2048 x 1536 pixels
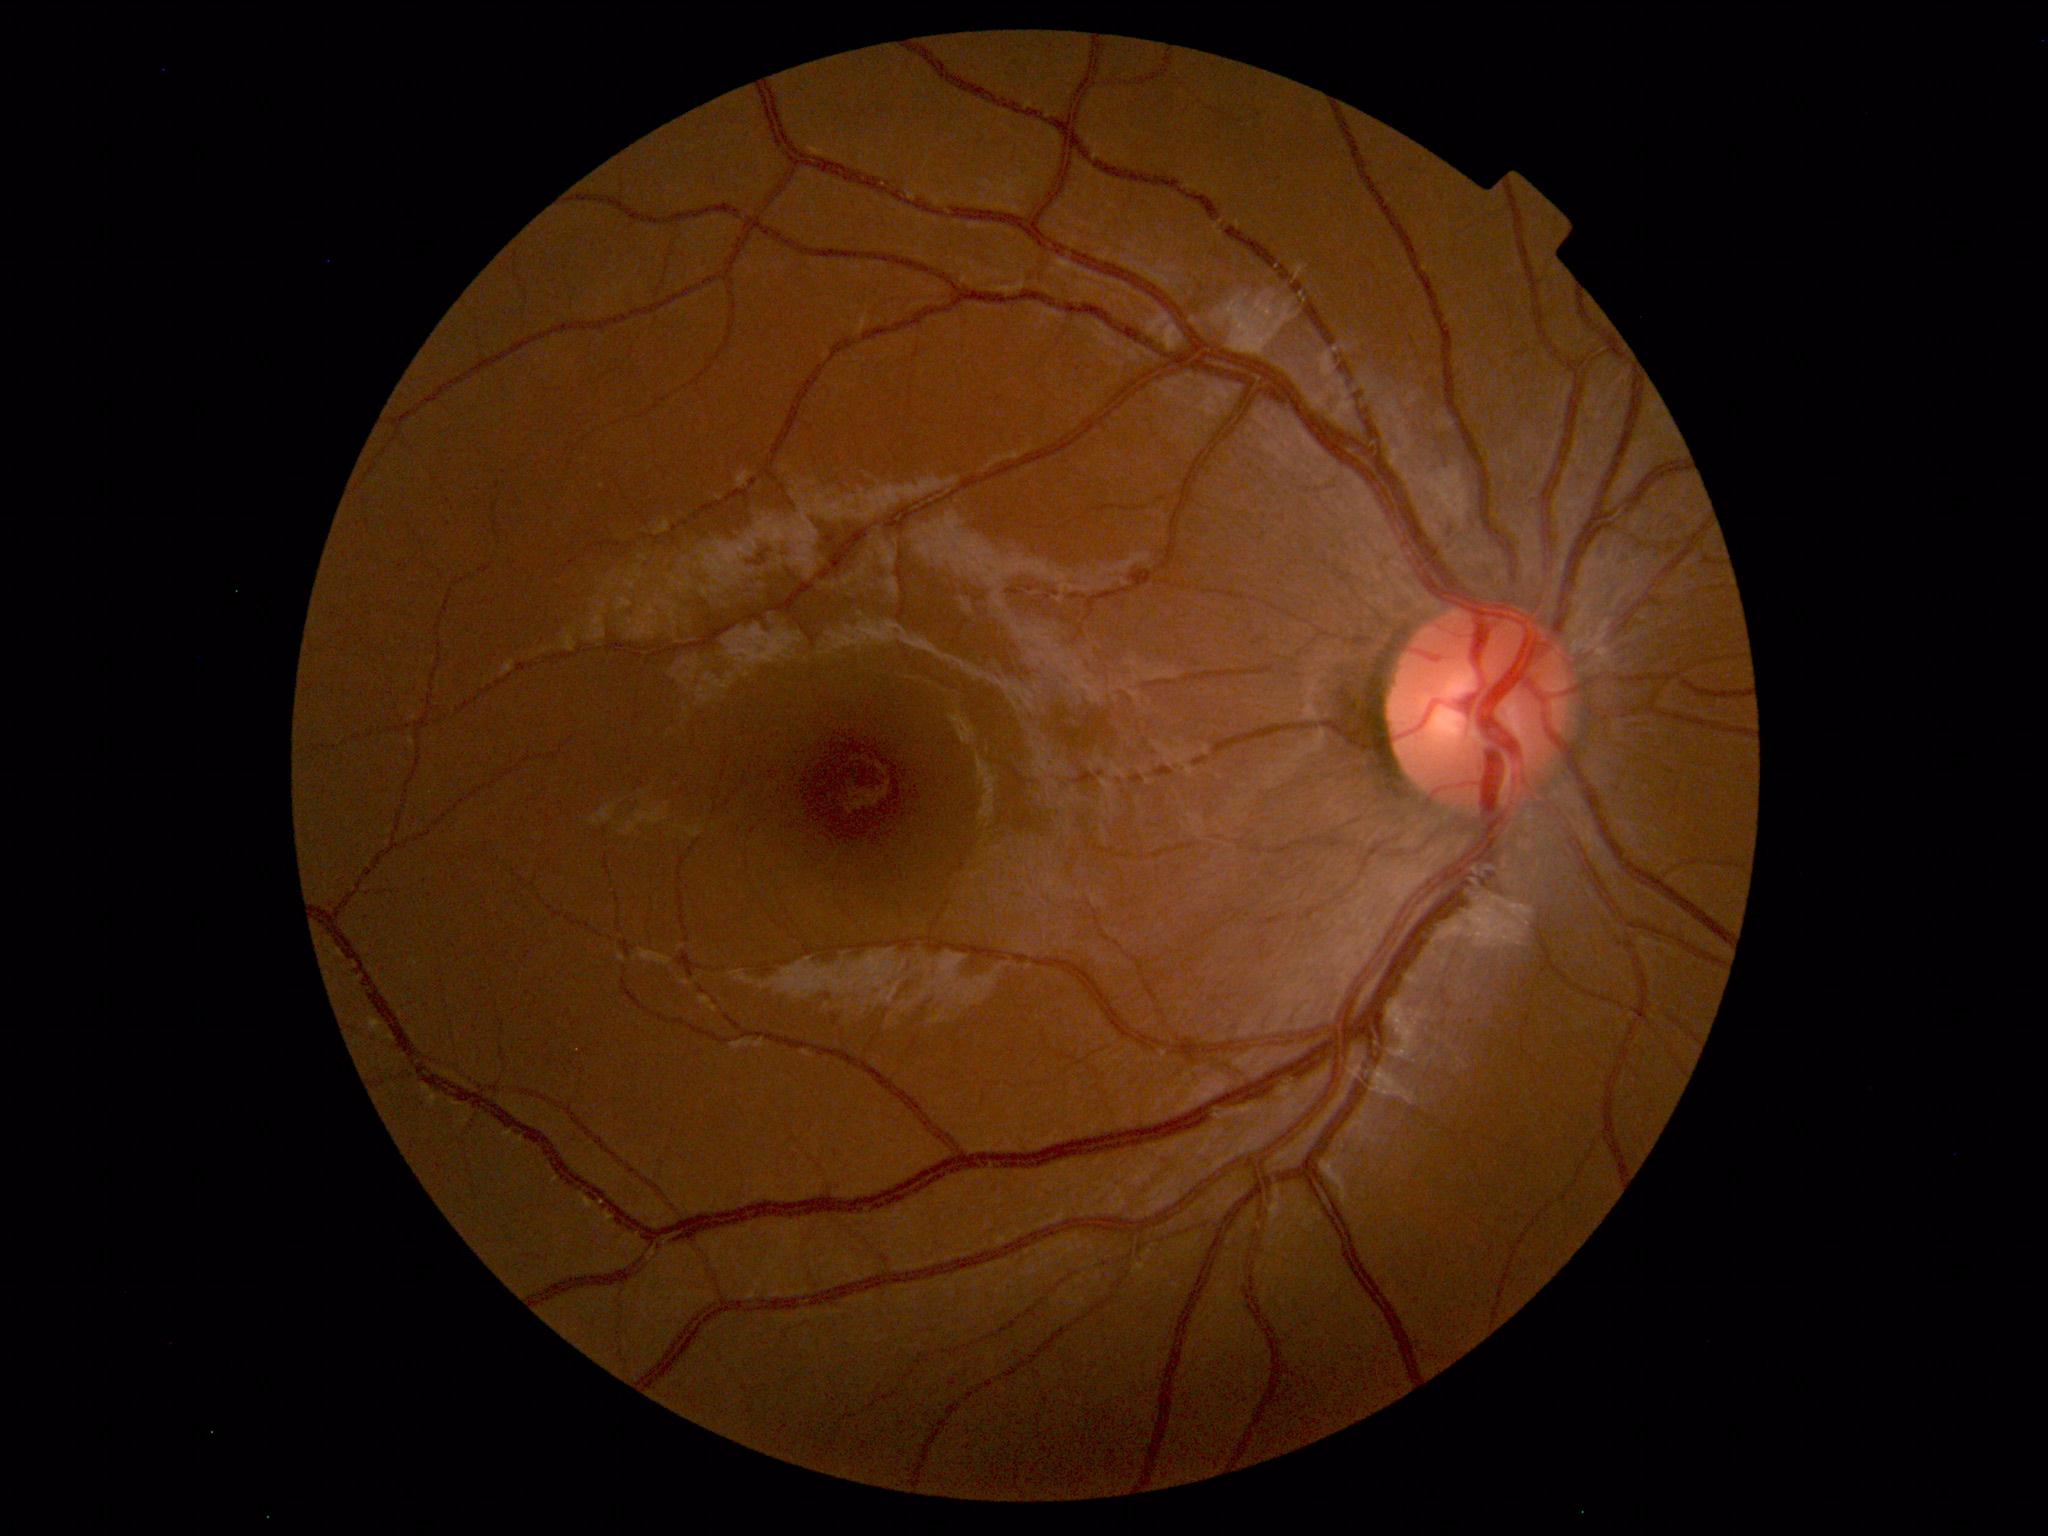

Findings: none. Normal fundus.